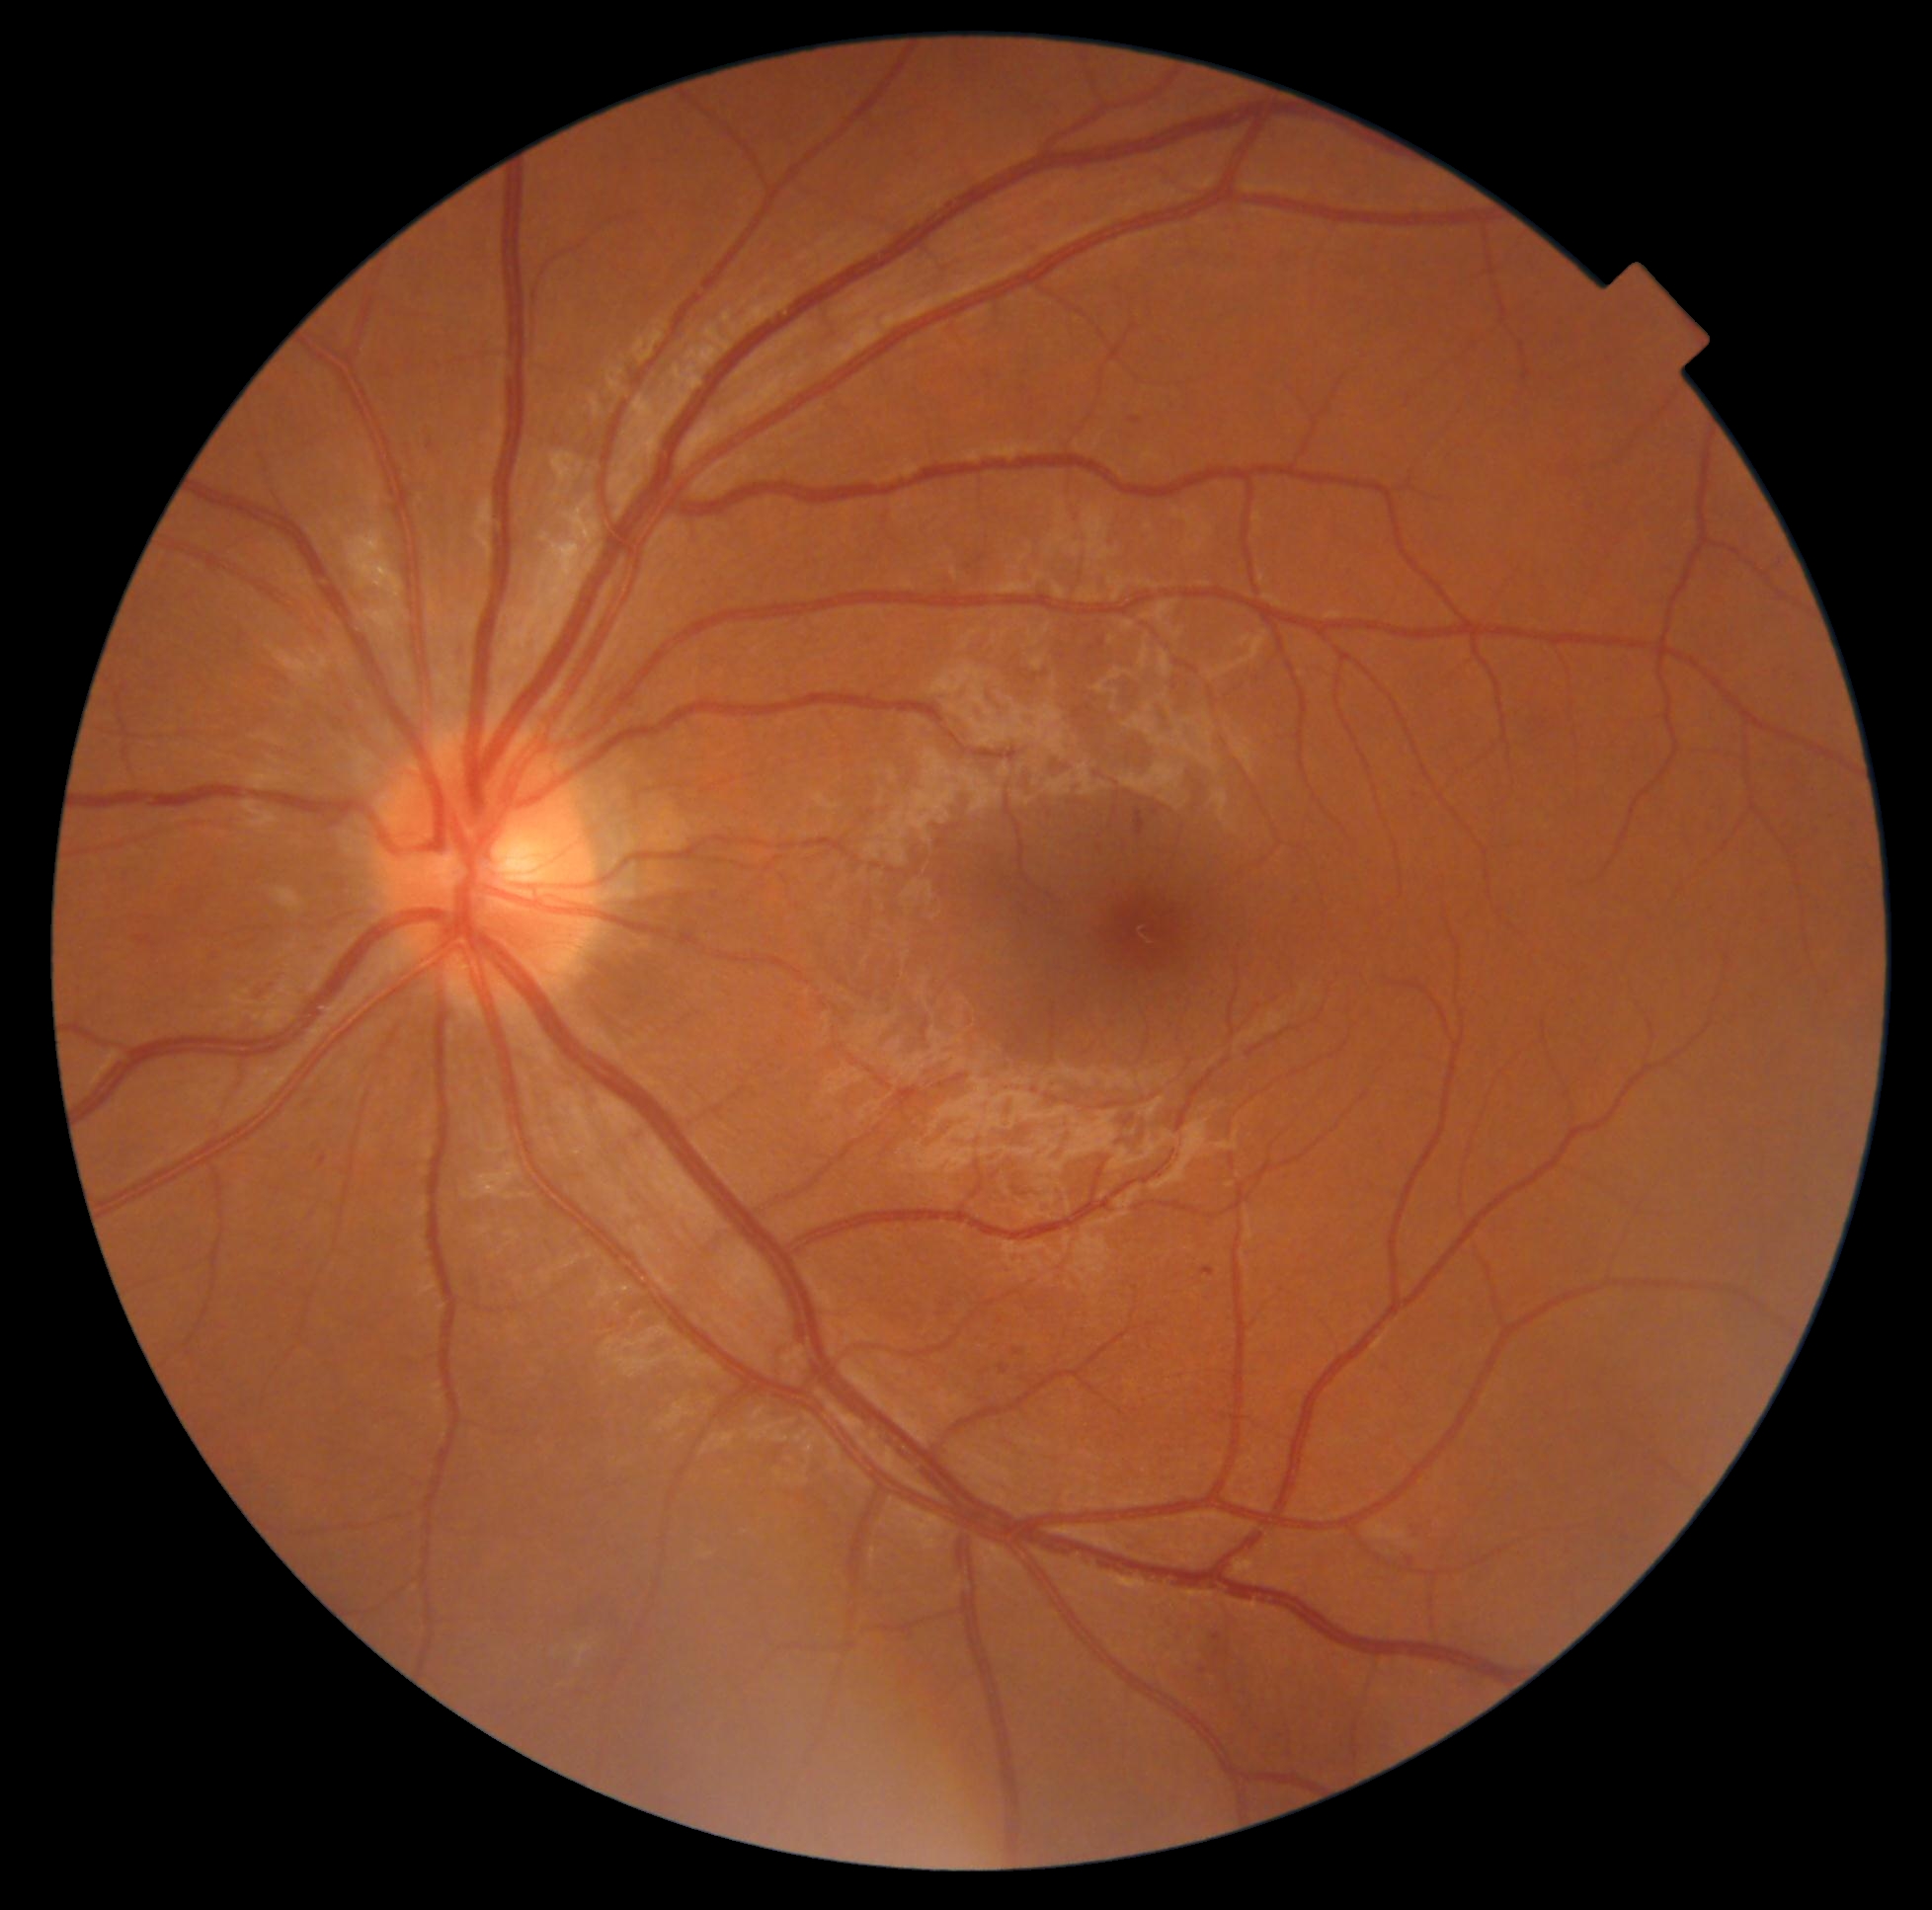

diabetic retinopathy (DR): grade 2.